Image size 2352x1568. 45° field of view.
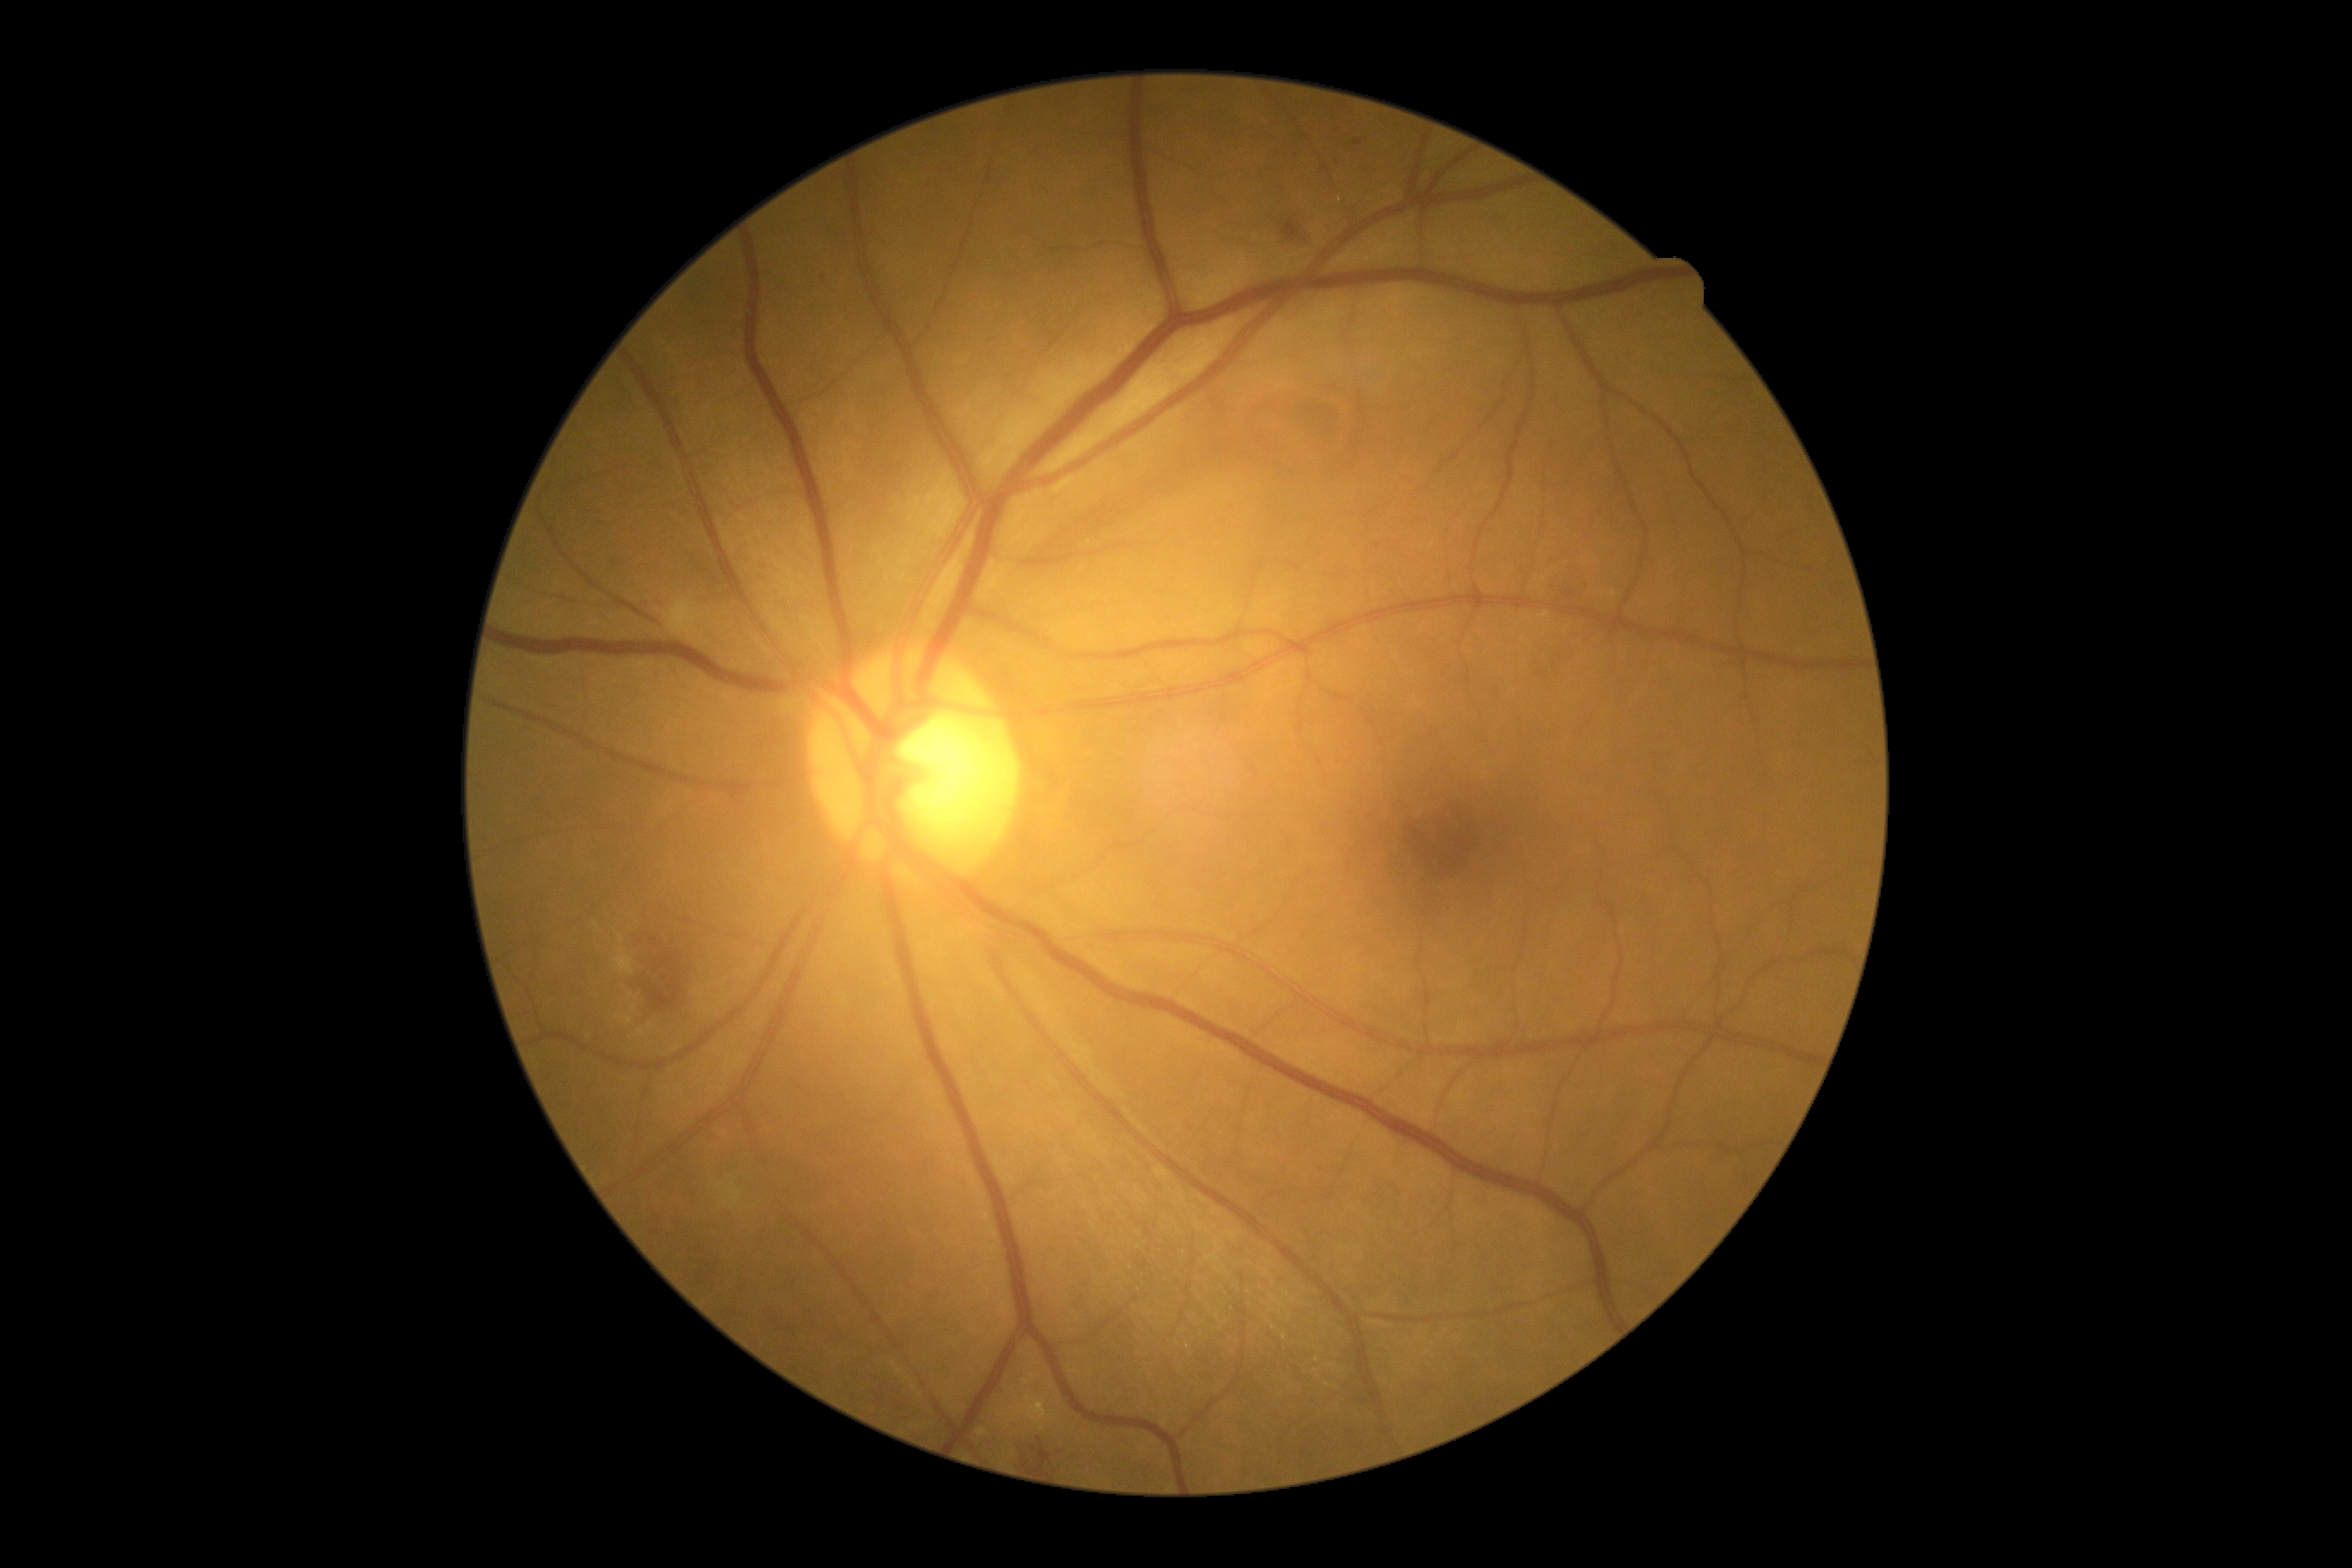 DR severity = grade 2 (moderate NPDR).